Fundus photo:
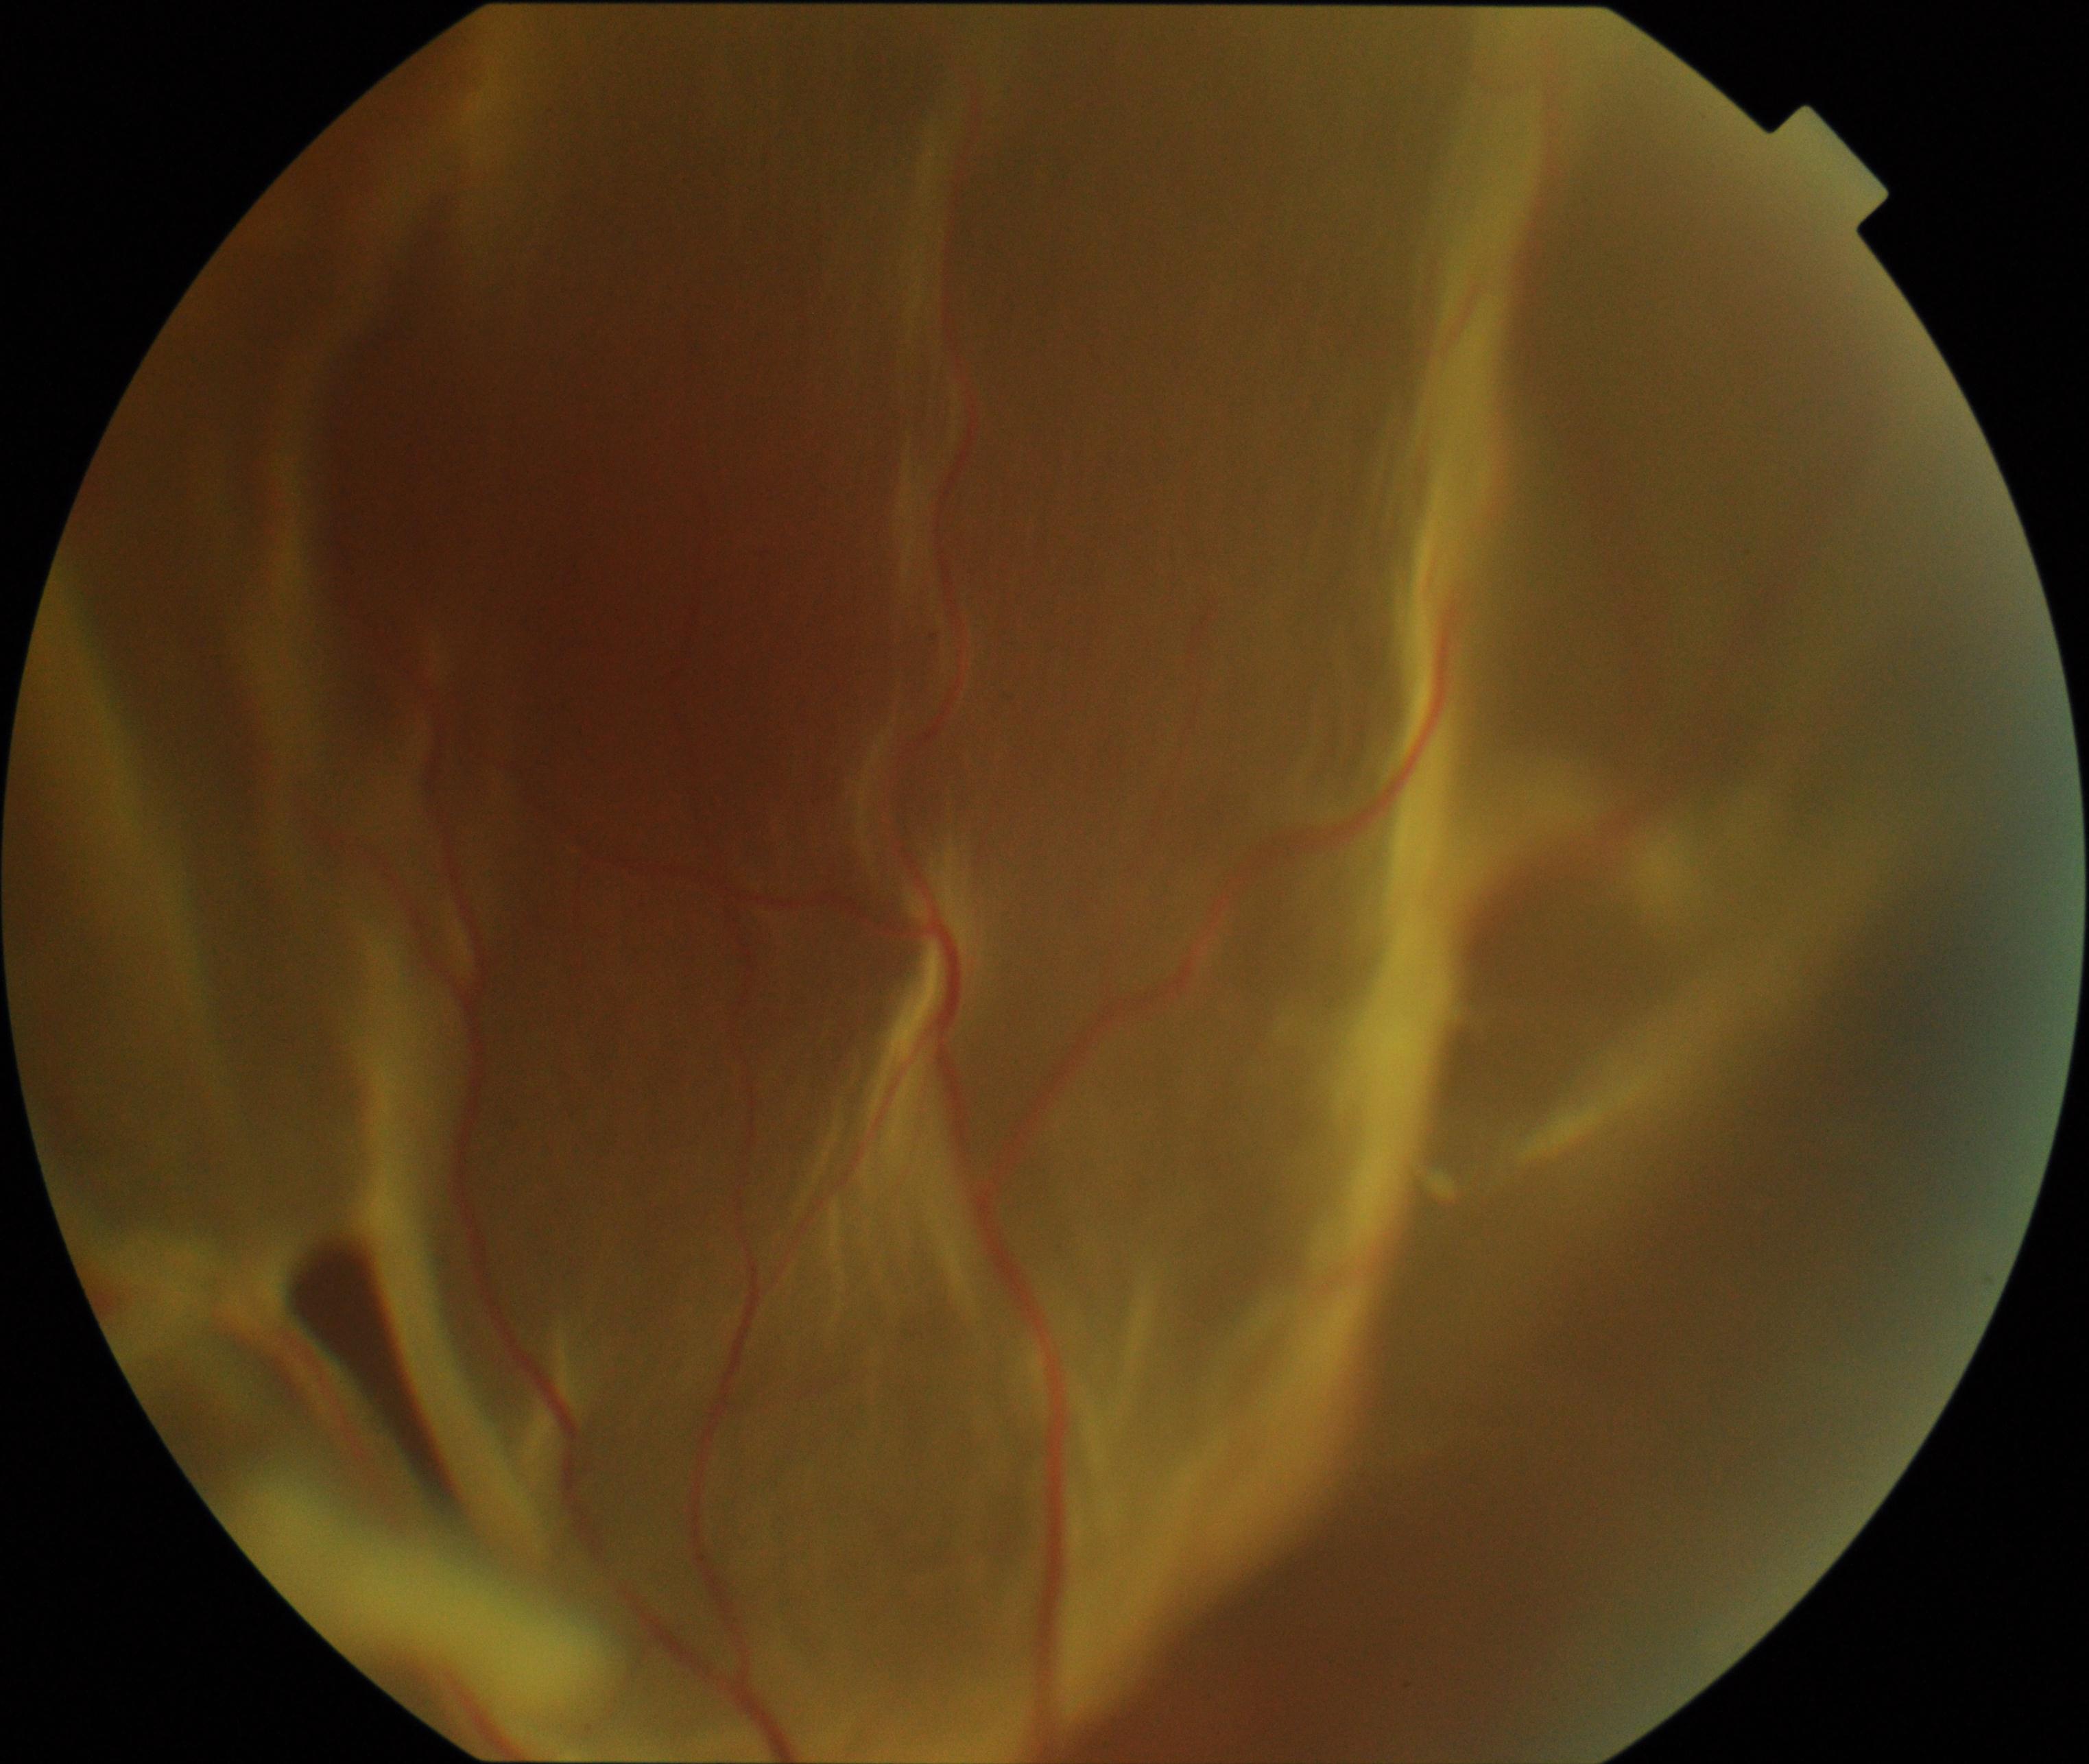
Consistent with rhegmatogenous retinal detachment.